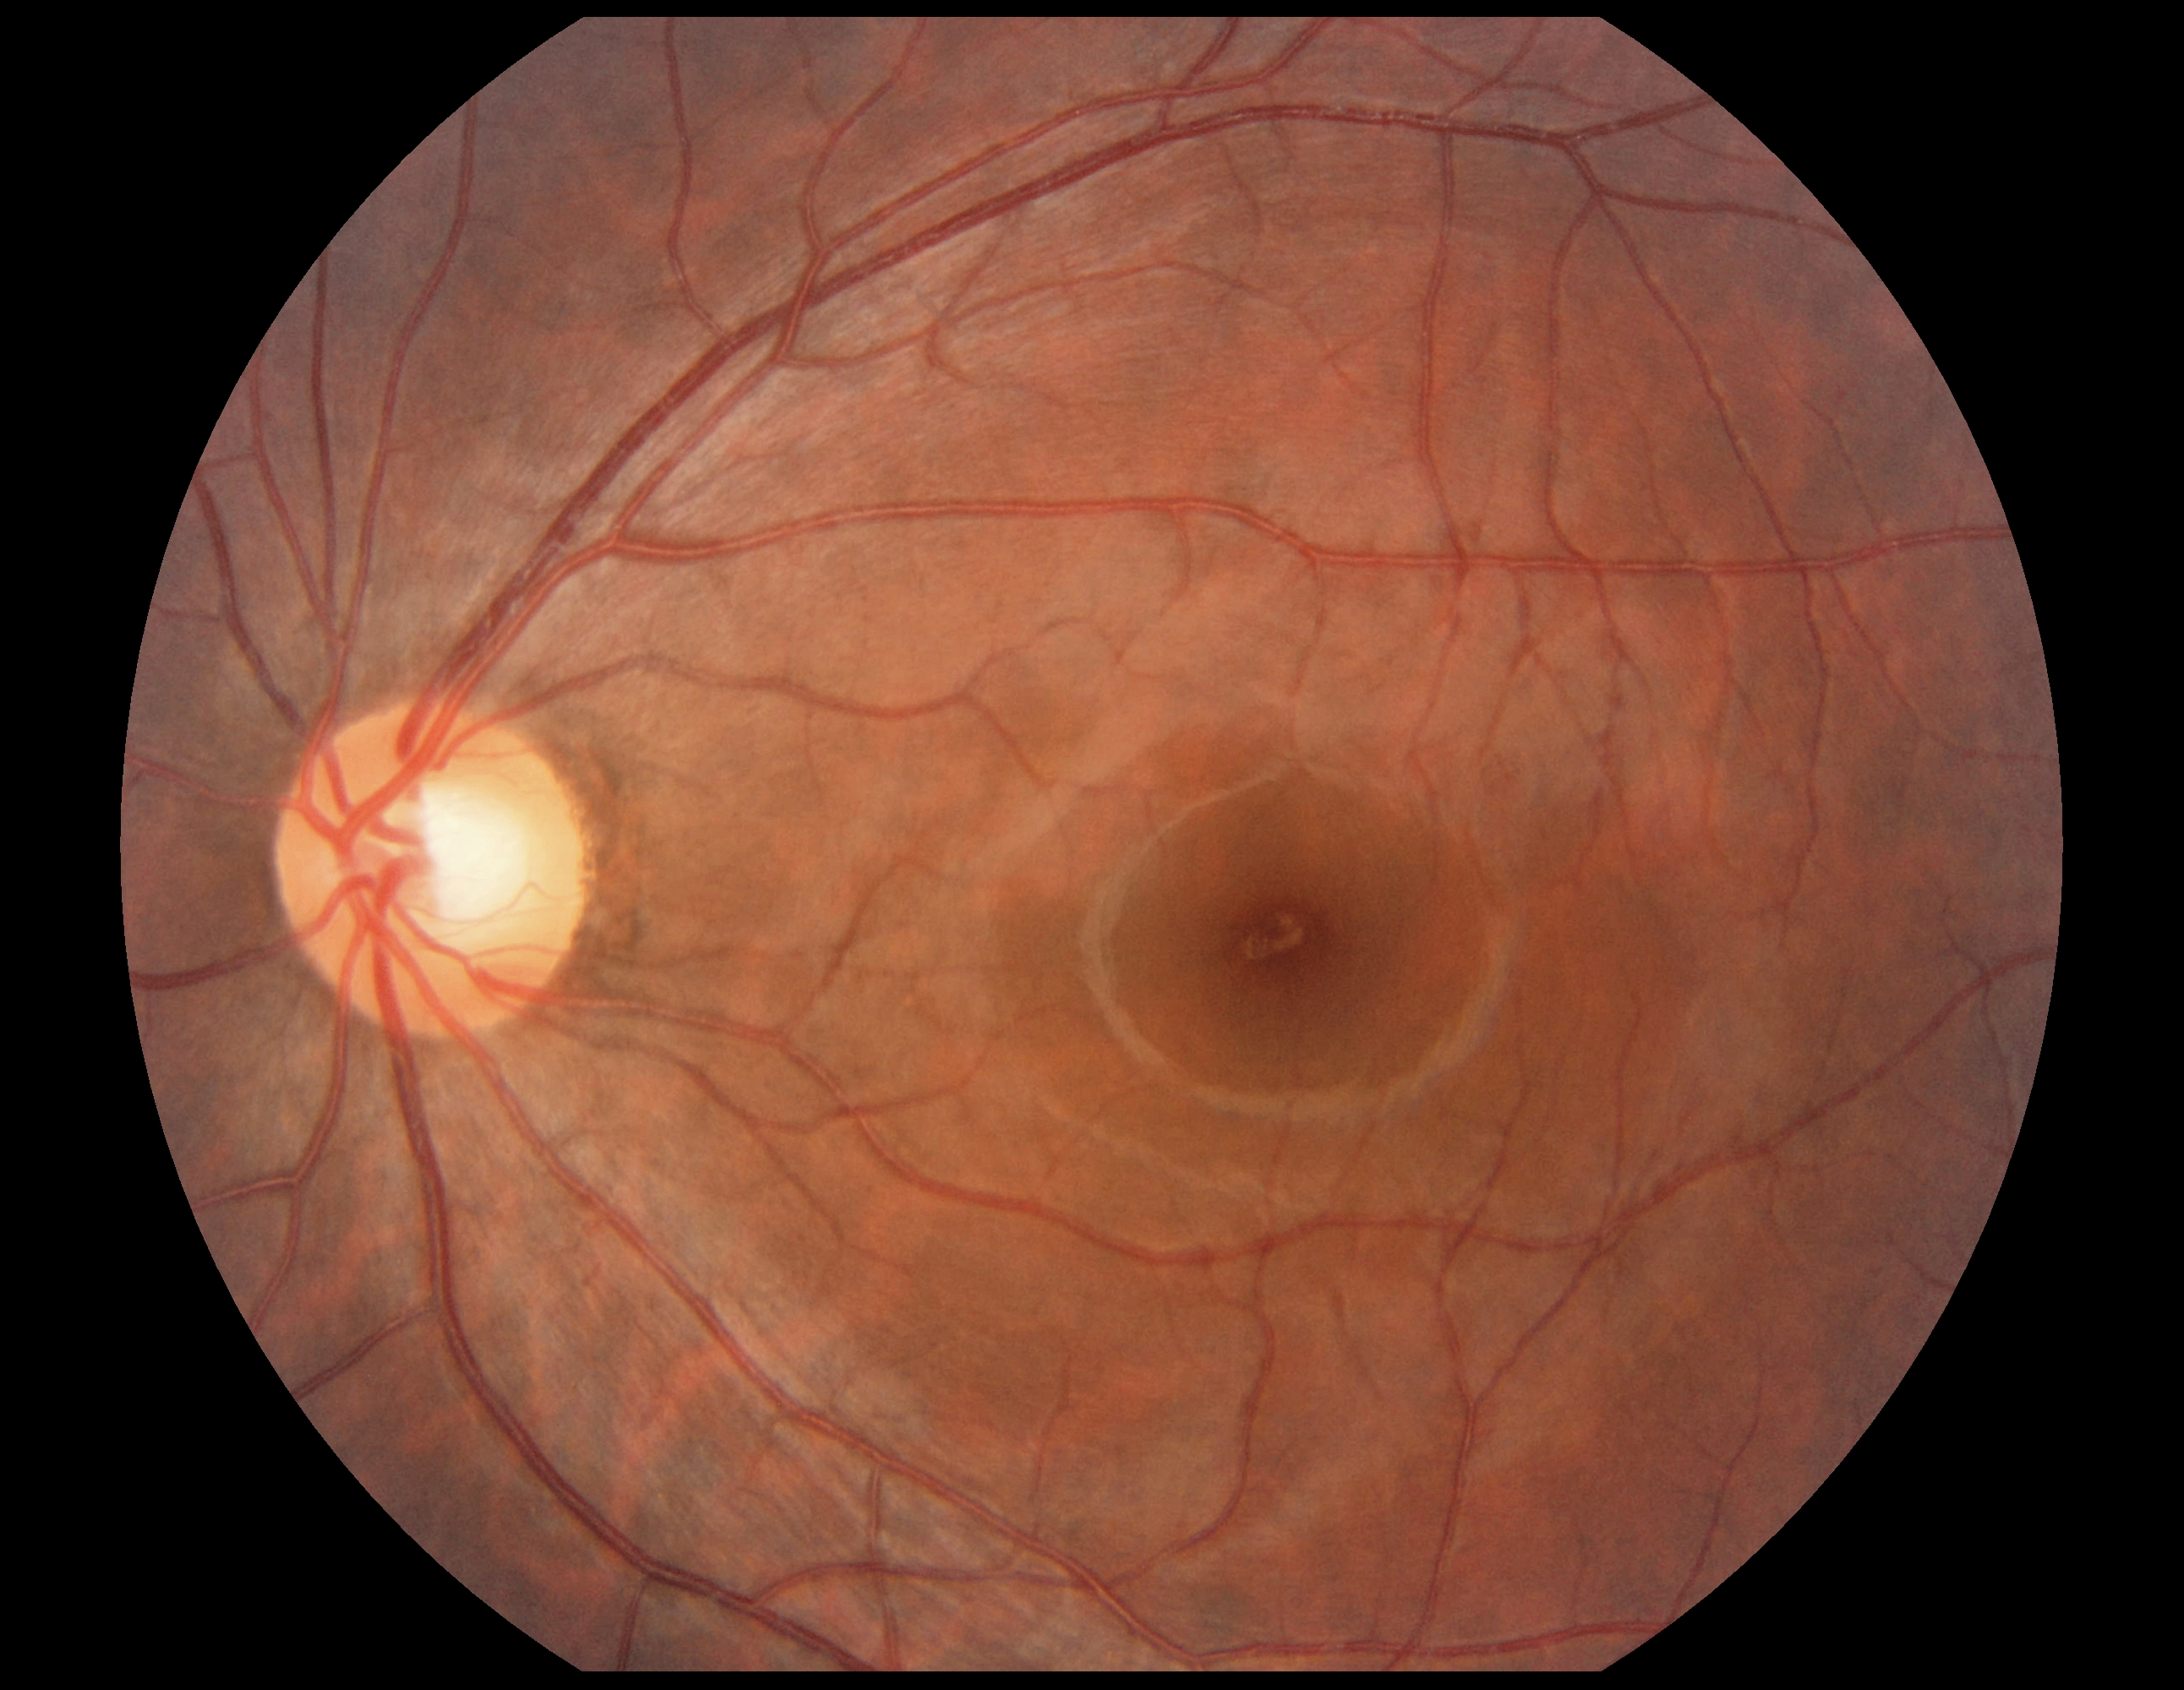 DR grade: no apparent diabetic retinopathy (0).